Posterior pole photograph; modified Davis classification.
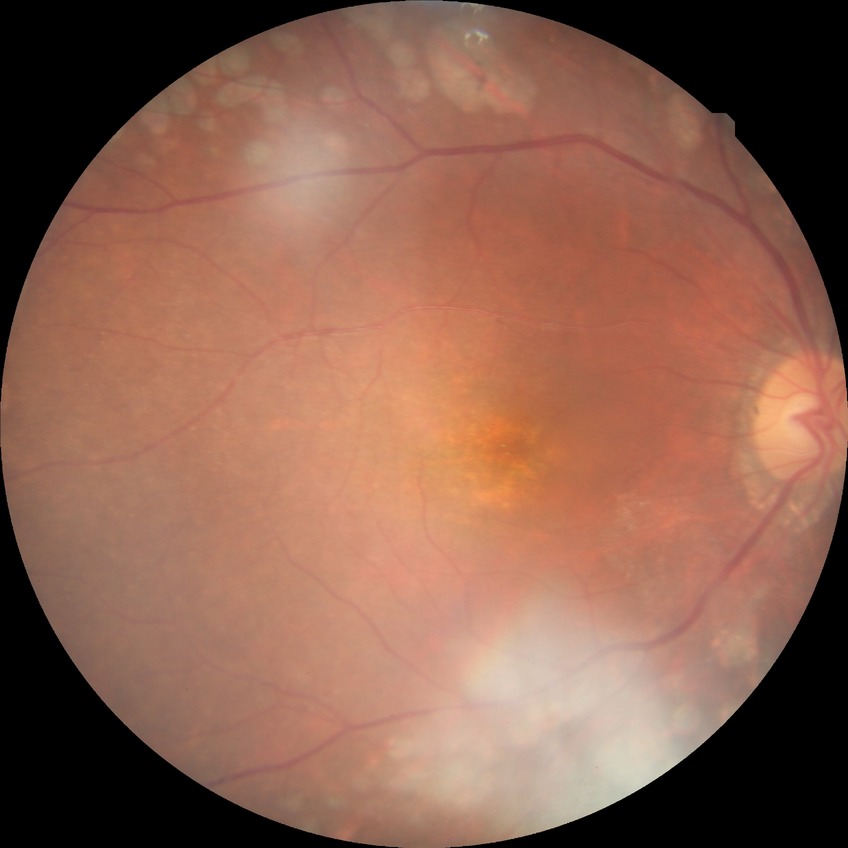

Annotations:
– diabetic retinopathy (DR): PDR (proliferative diabetic retinopathy)